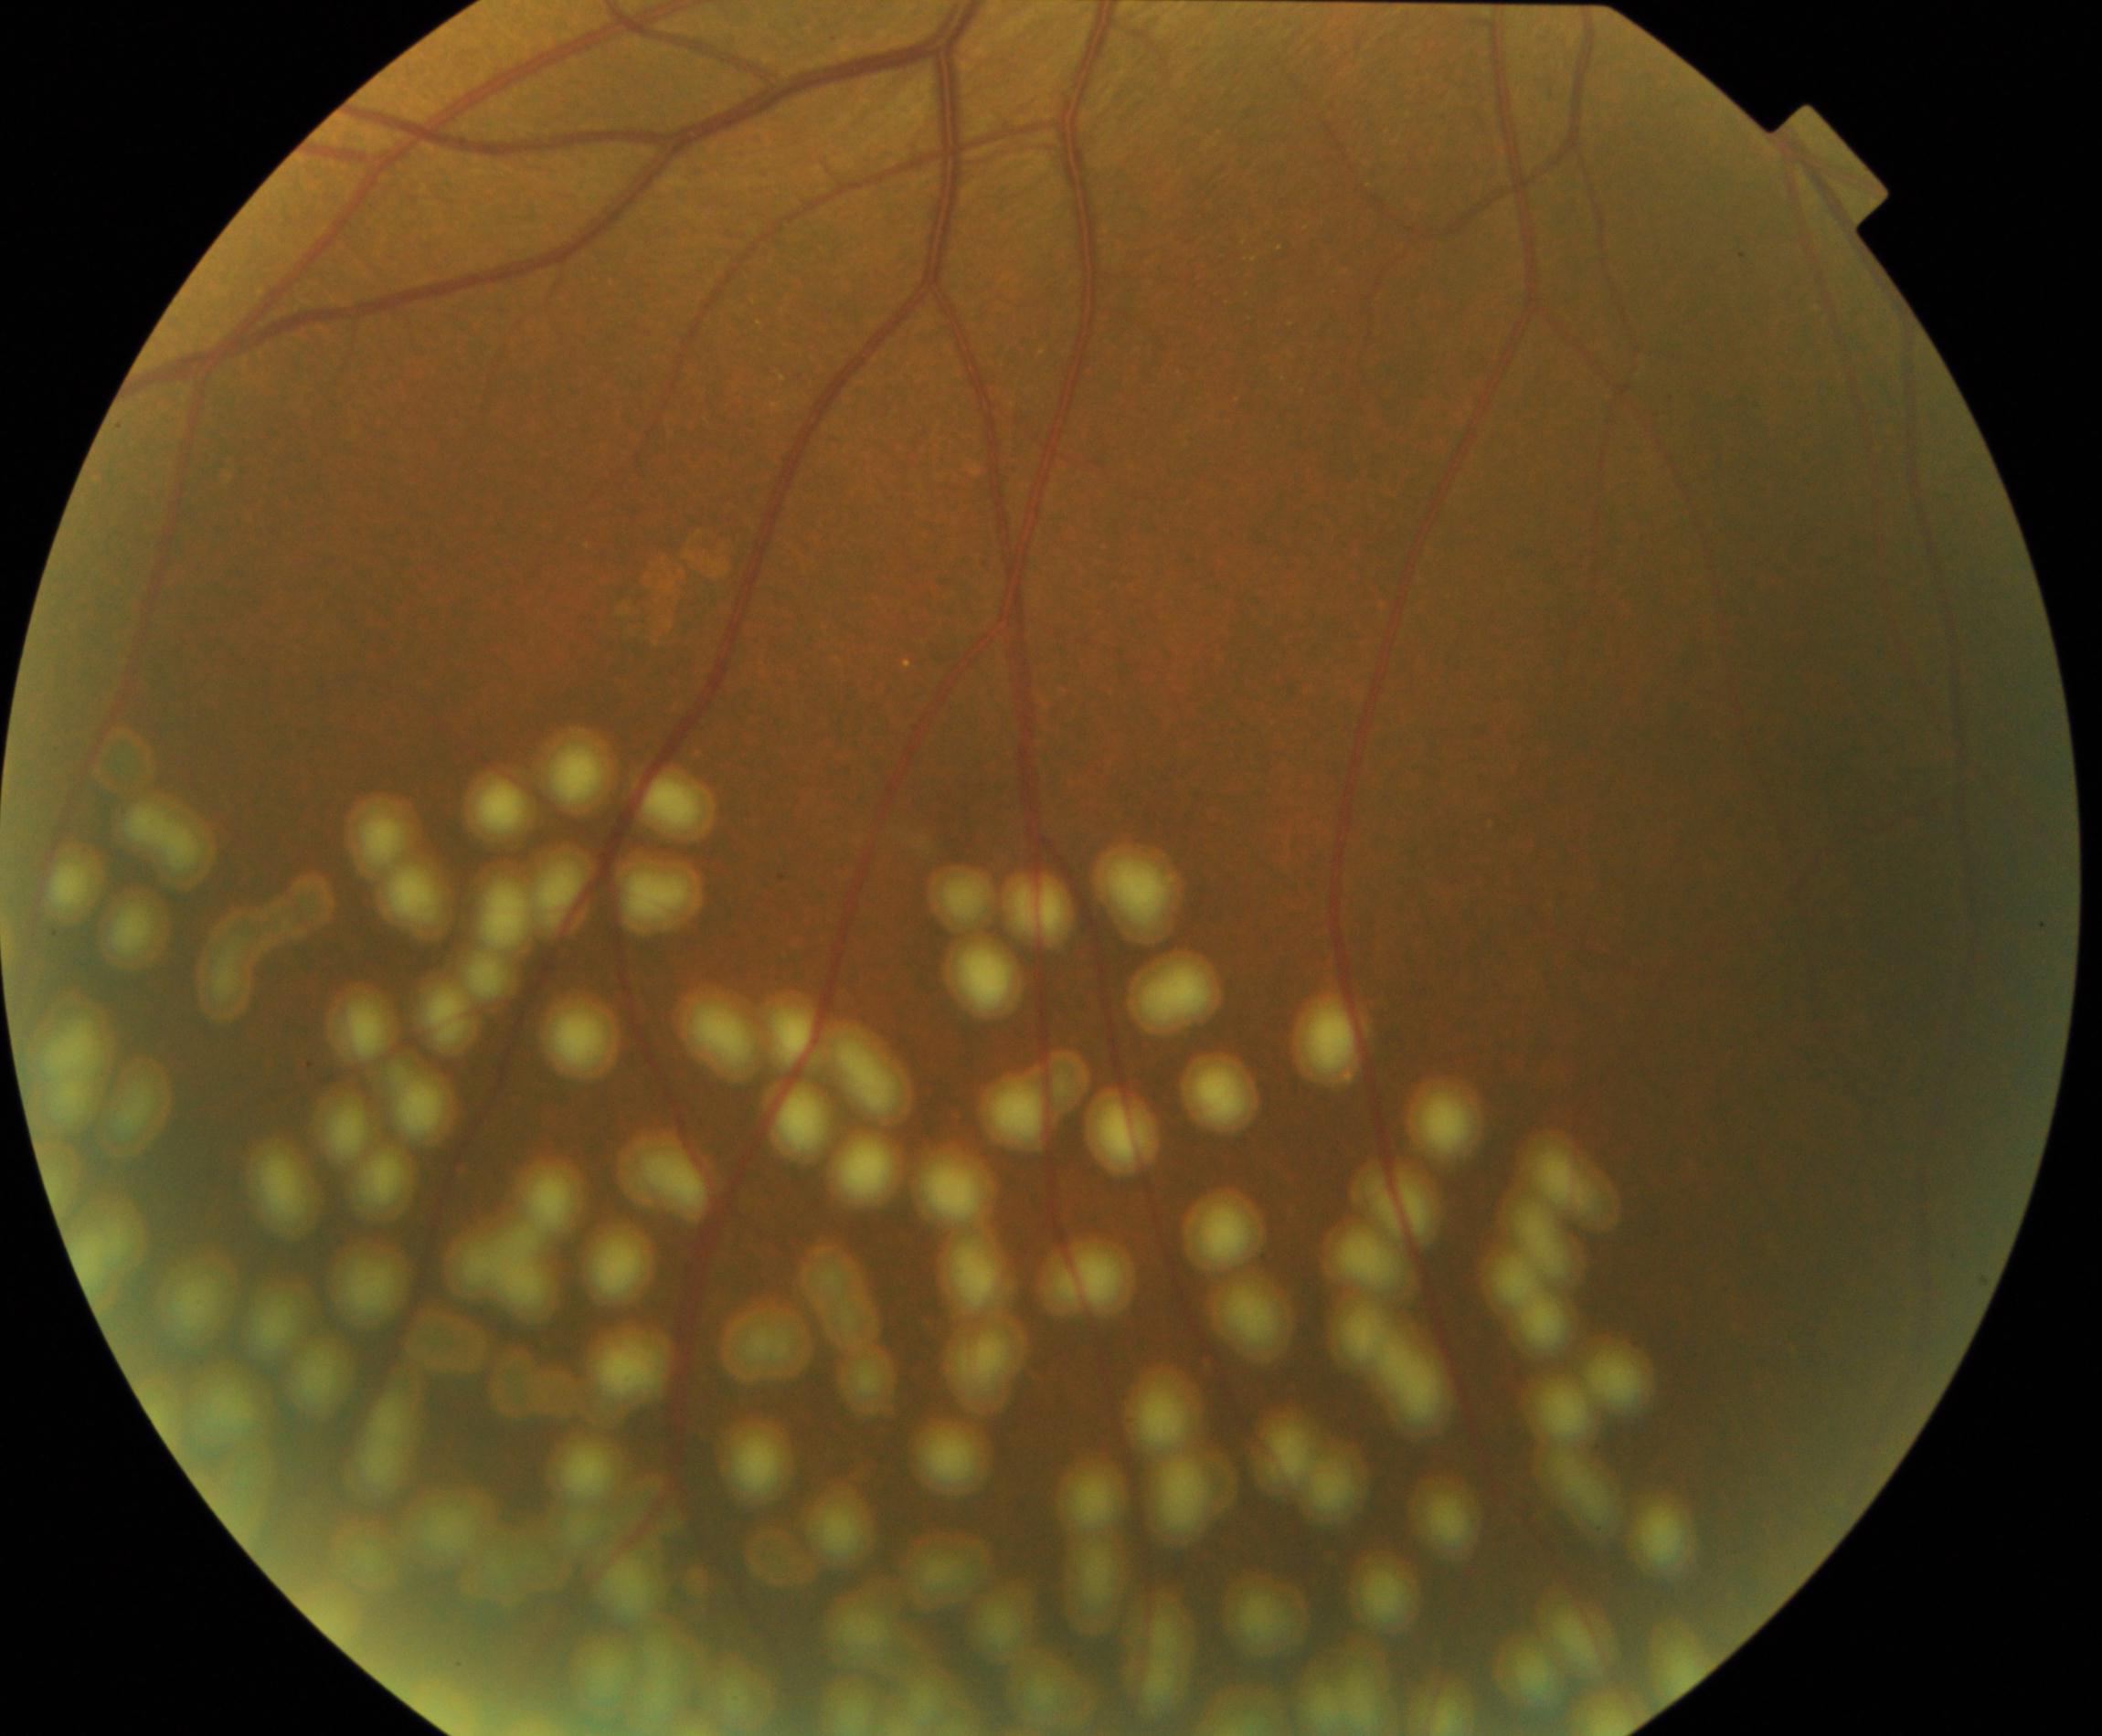

Treatment history: laser spots.